45° FOV; 1536x1152px; retinal fundus photograph.
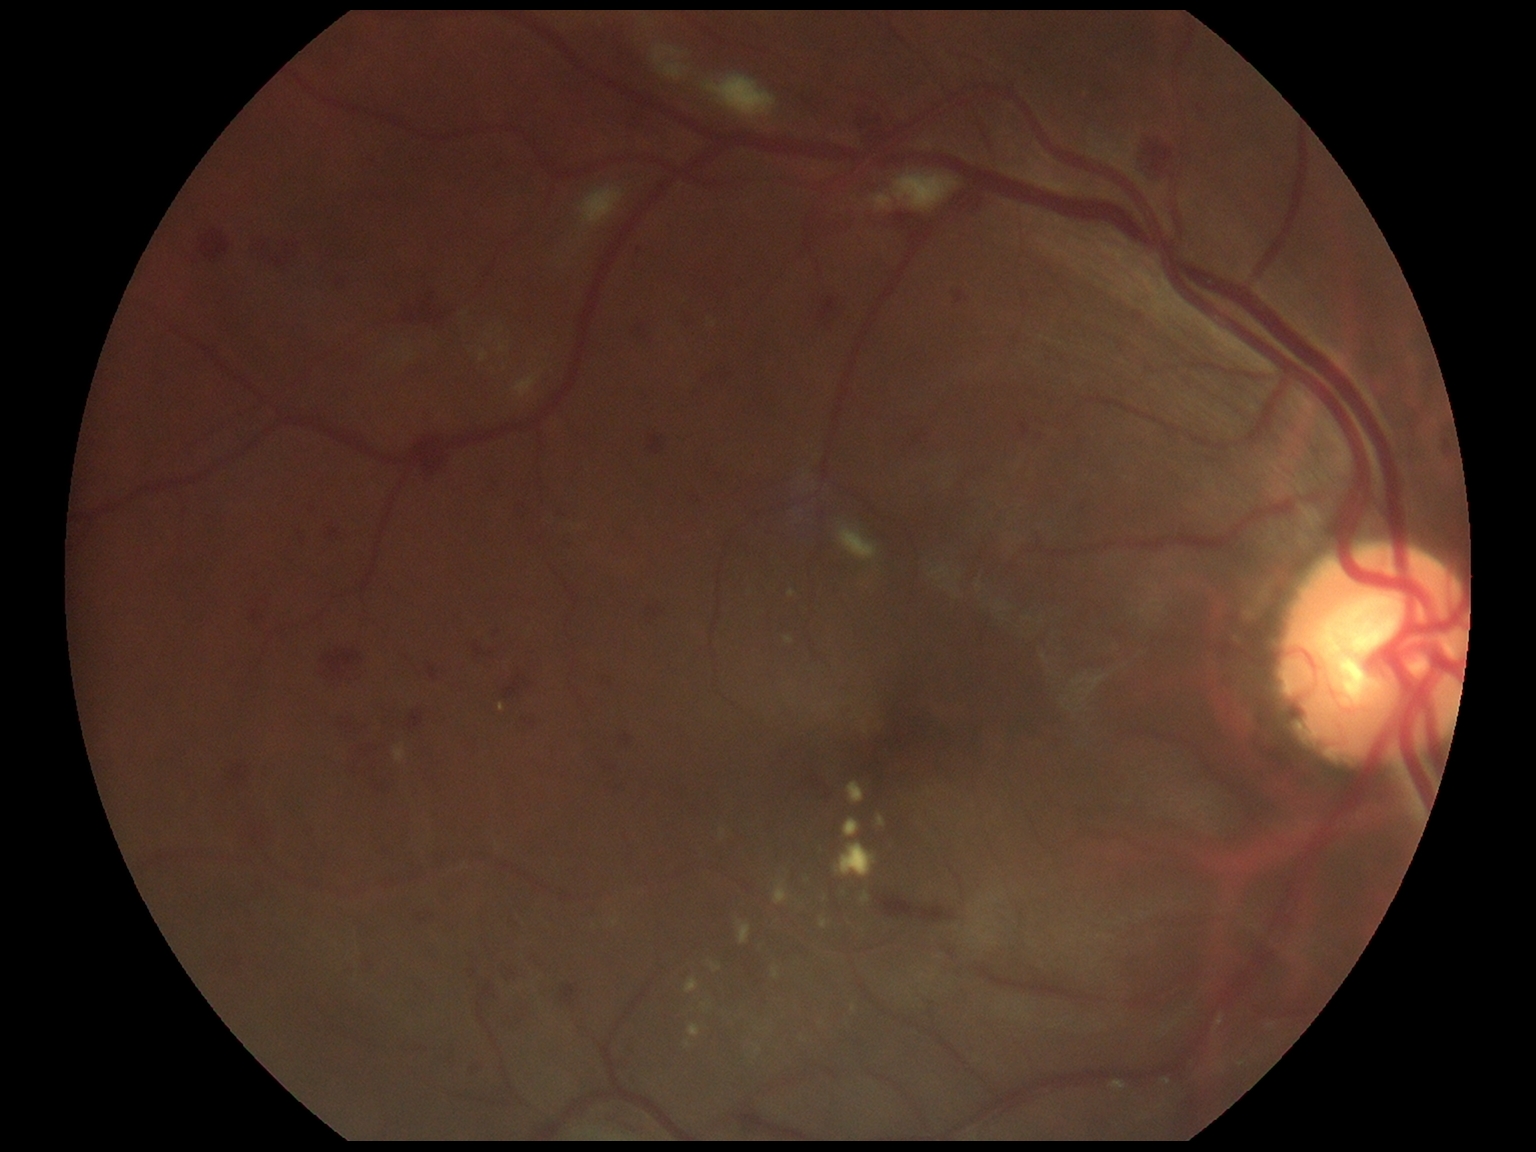

Diabetic retinopathy (DR): grade 2.